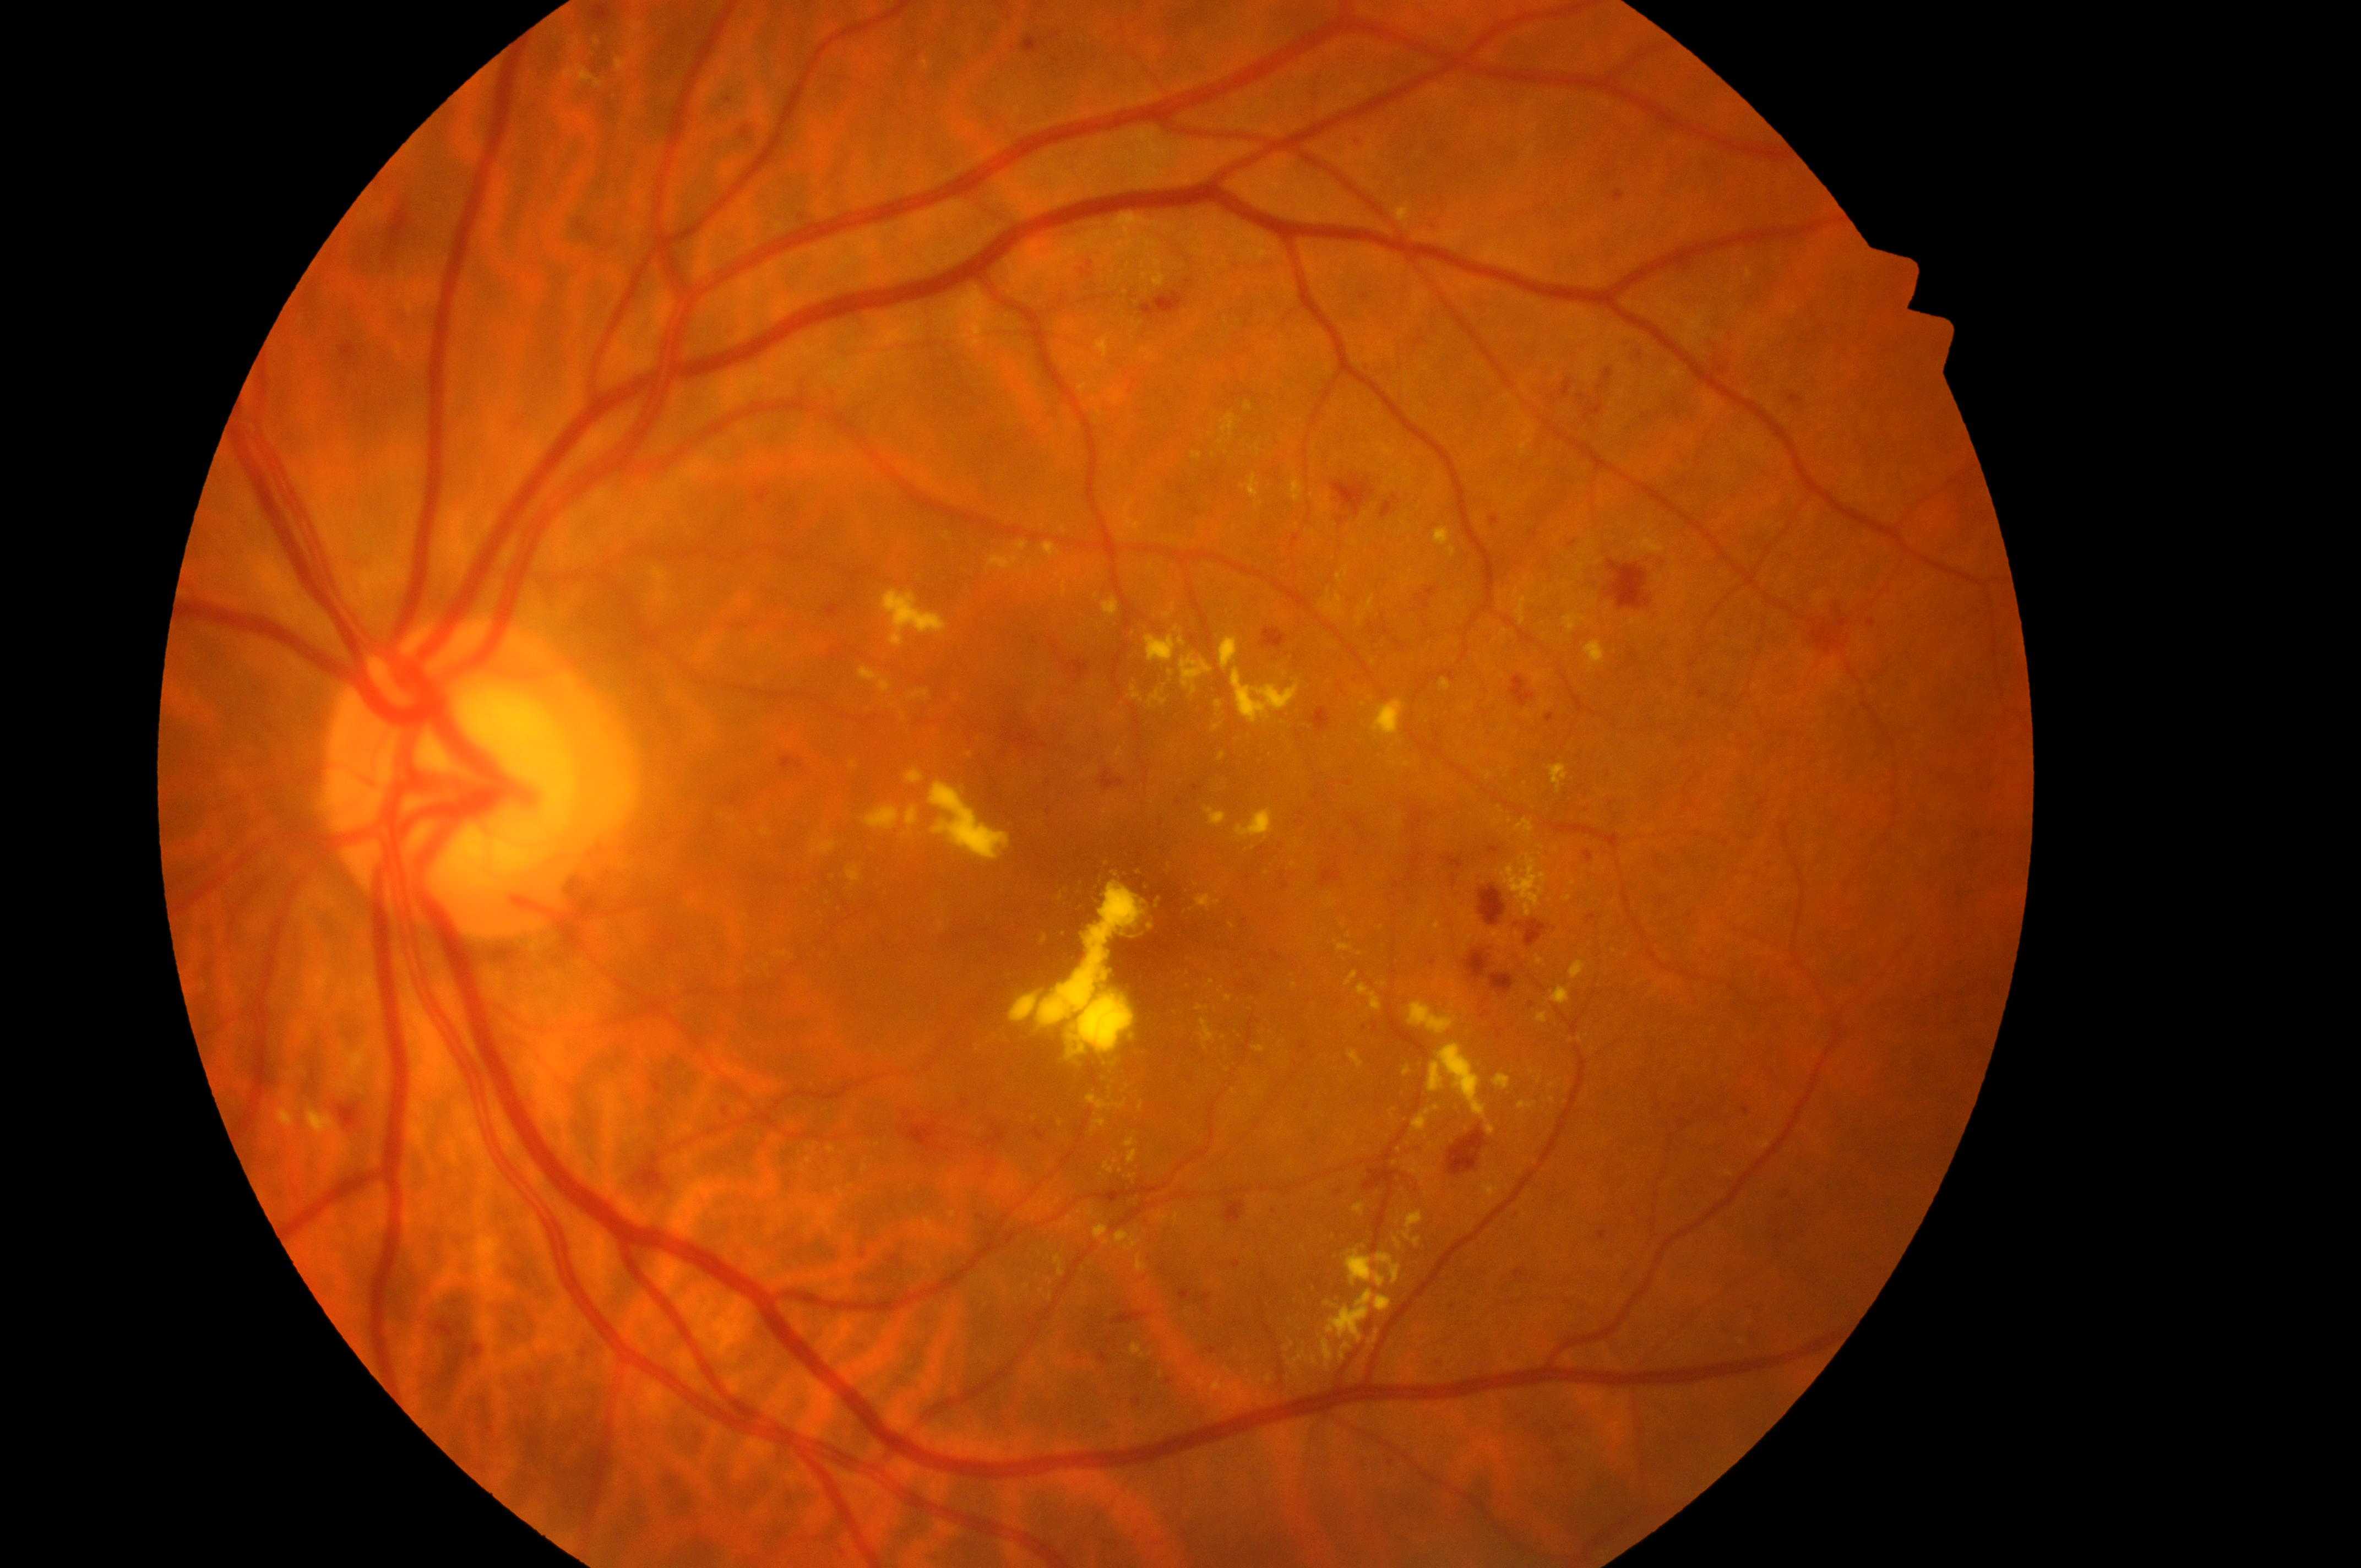

DR class: proliferative diabetic retinopathy.
Macula center located at 1149, 922.
Macular edema: grade 2.
The optic nerve head is at 466, 785.
Retinopathy is 4/4.
Eye: the left eye.